Diabetic retinopathy graded by the modified Davis classification · posterior pole photograph — 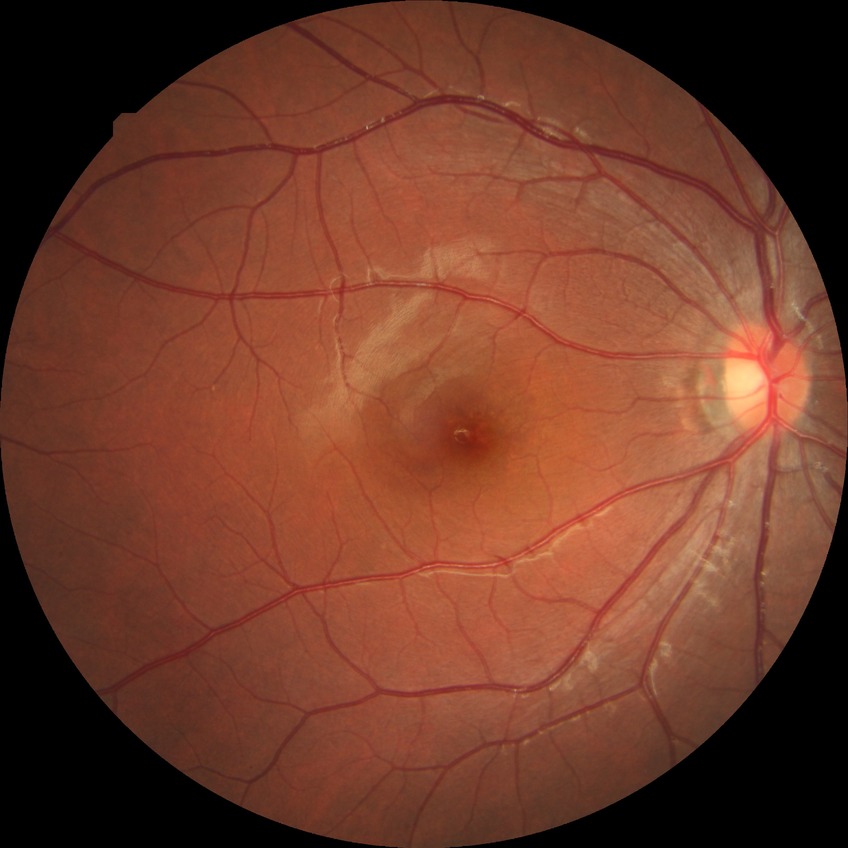 - modified Davis grading: no diabetic retinopathy